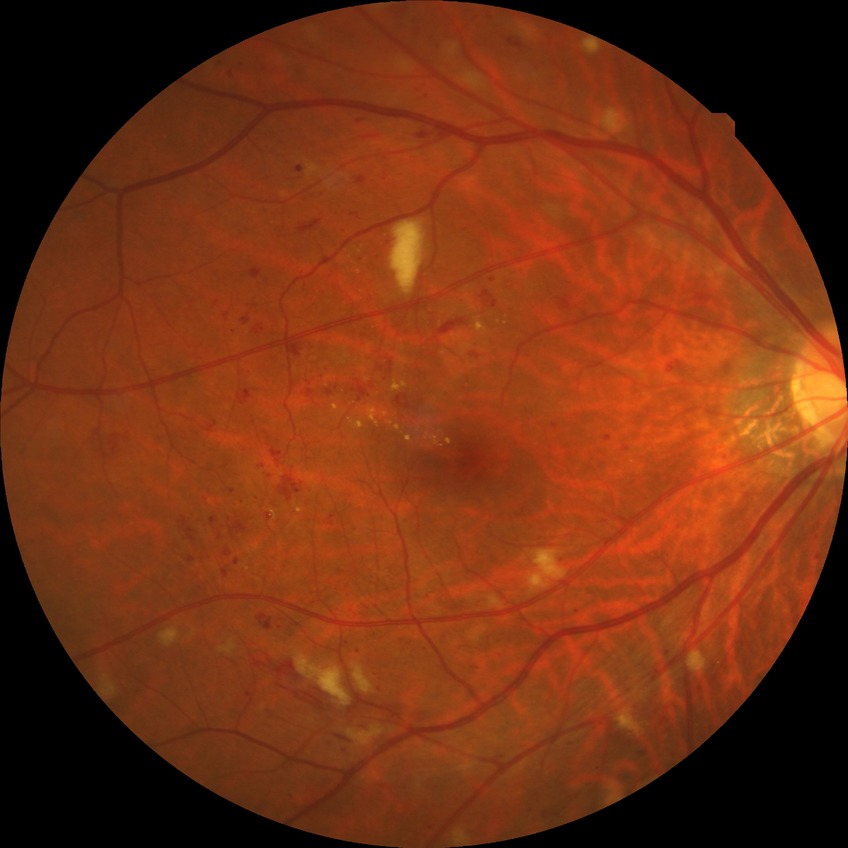
diabetic retinopathy stage: pre-proliferative diabetic retinopathy.